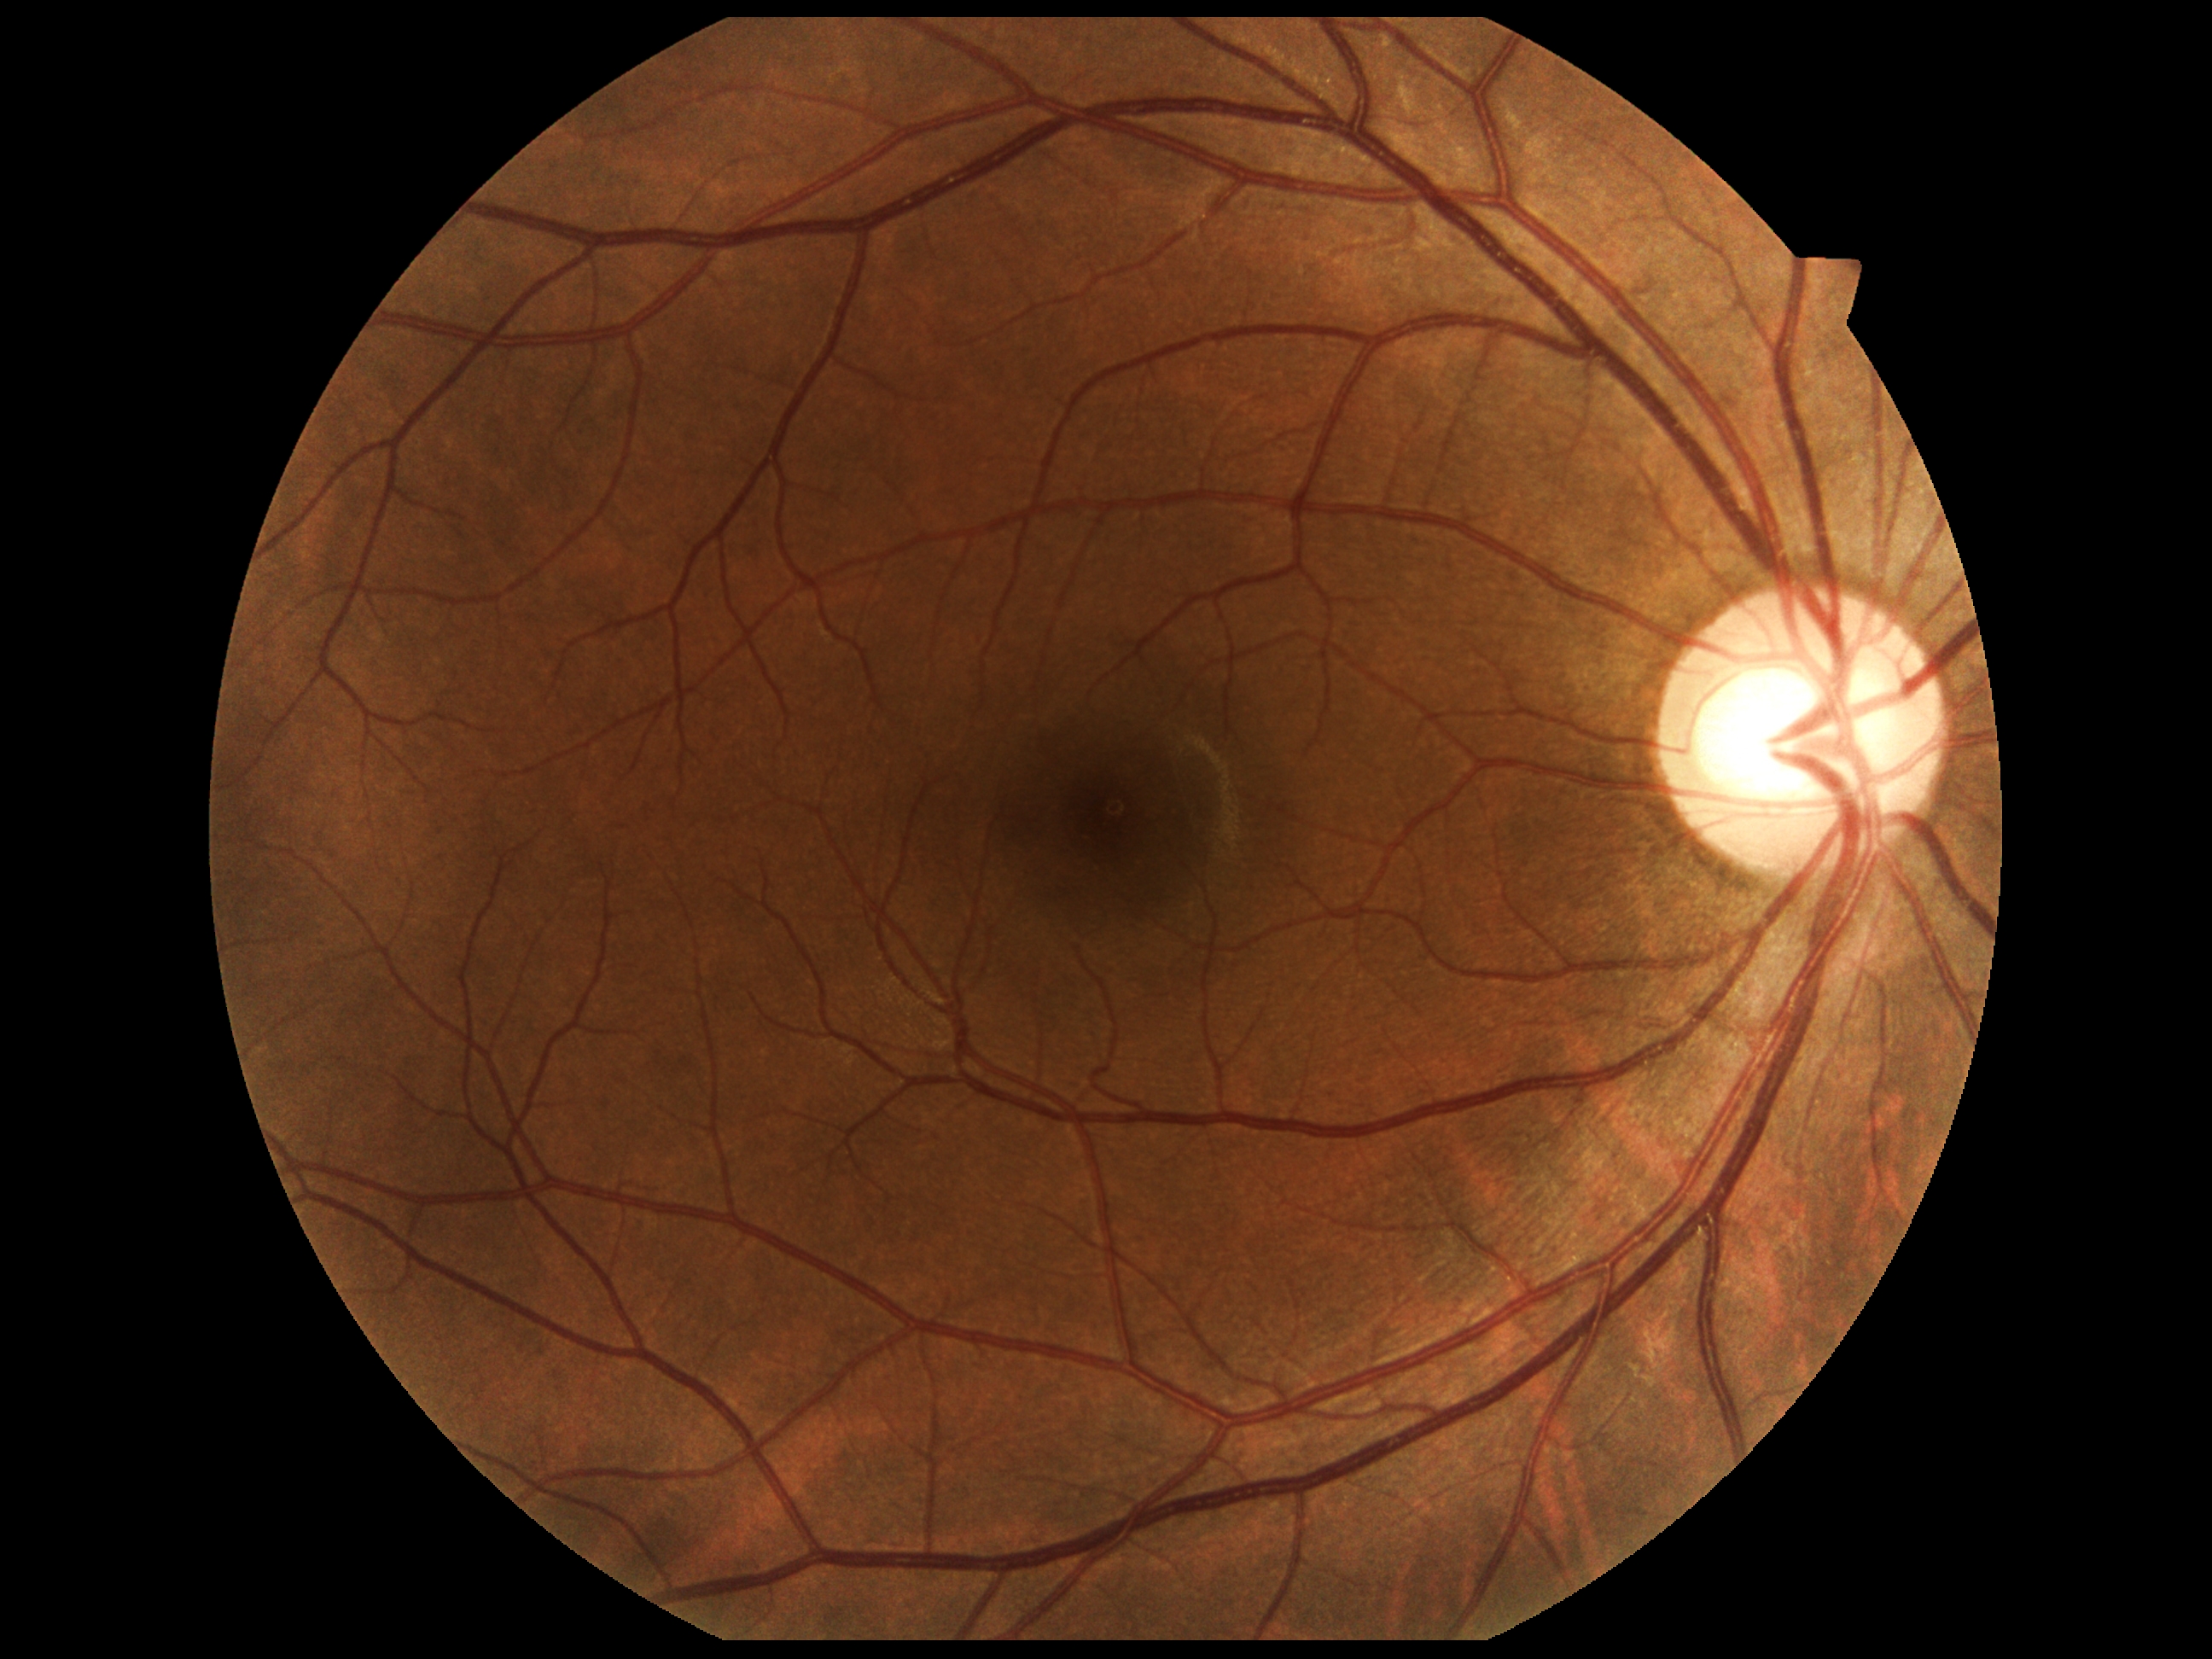
Diabetic retinopathy severity is grade 0.